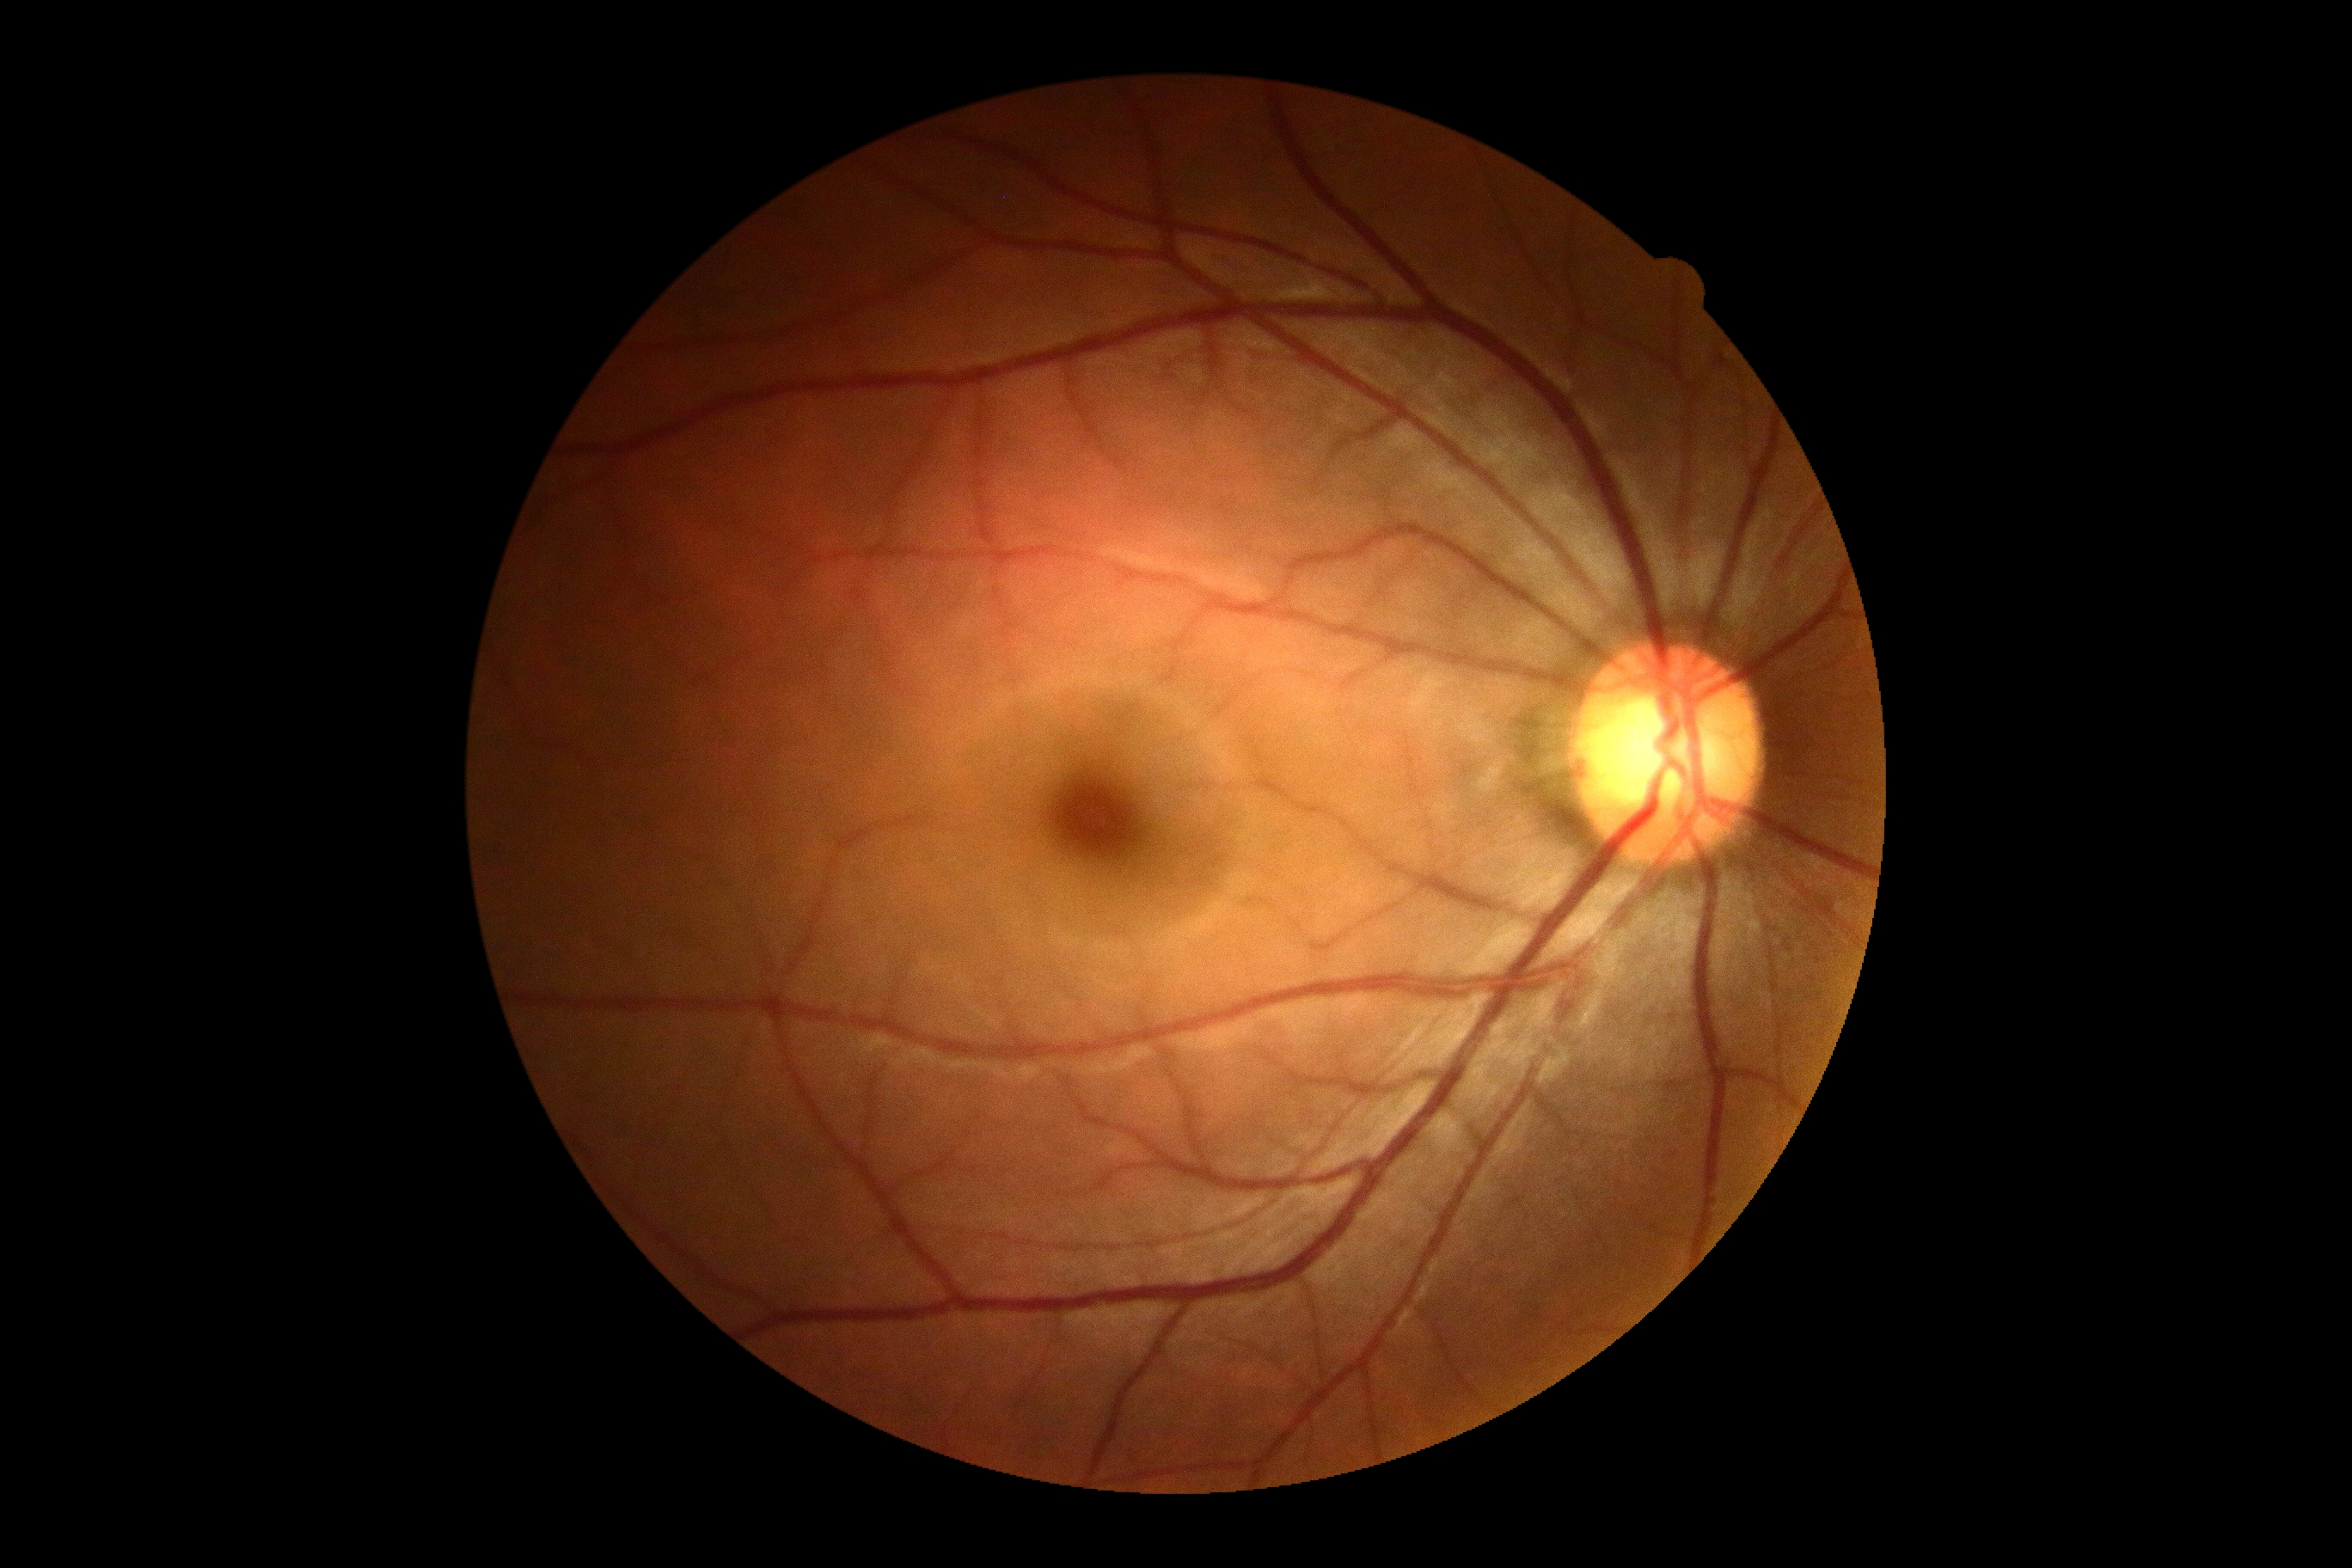 No signs of diabetic retinopathy. Diabetic retinopathy severity: 0/4.